Image size 512x512
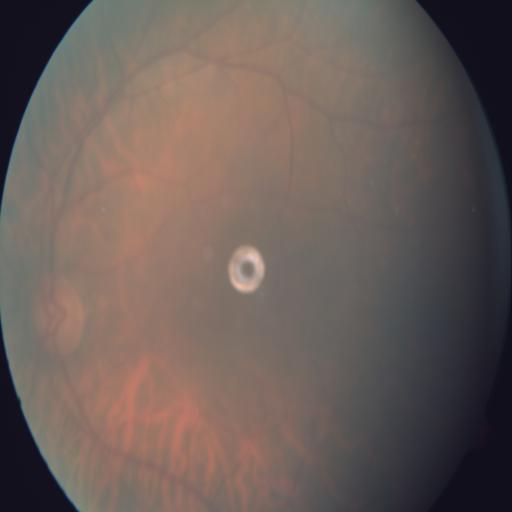 Findings consistent with tessellation (TSLN).